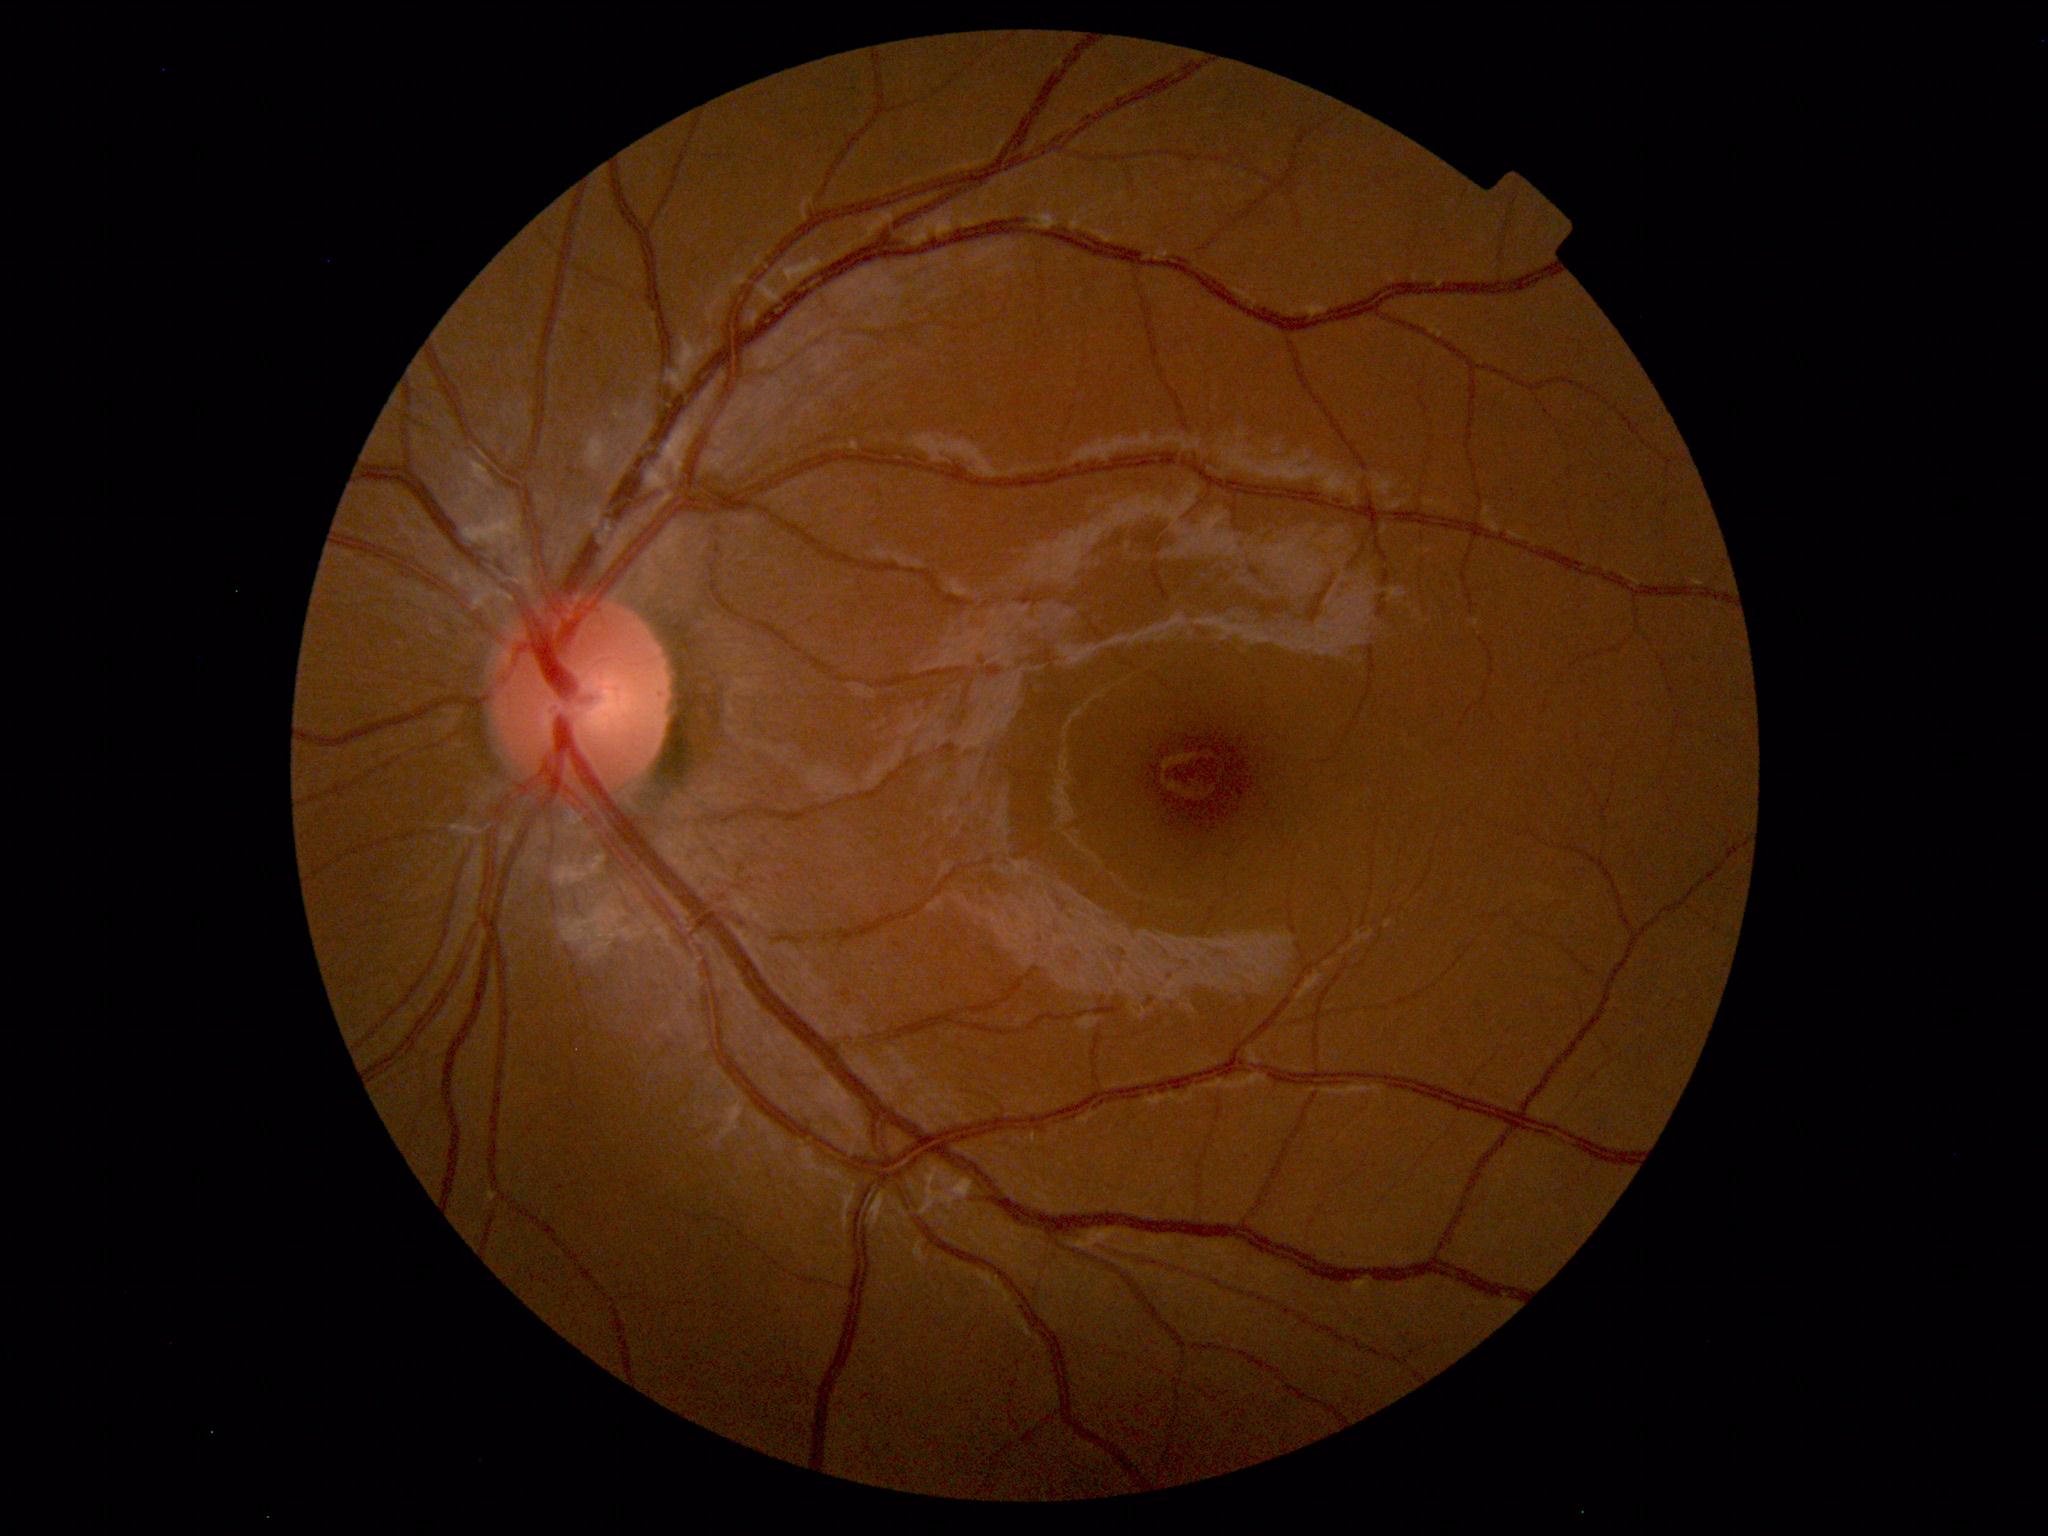
Unremarkable color fundus photograph.